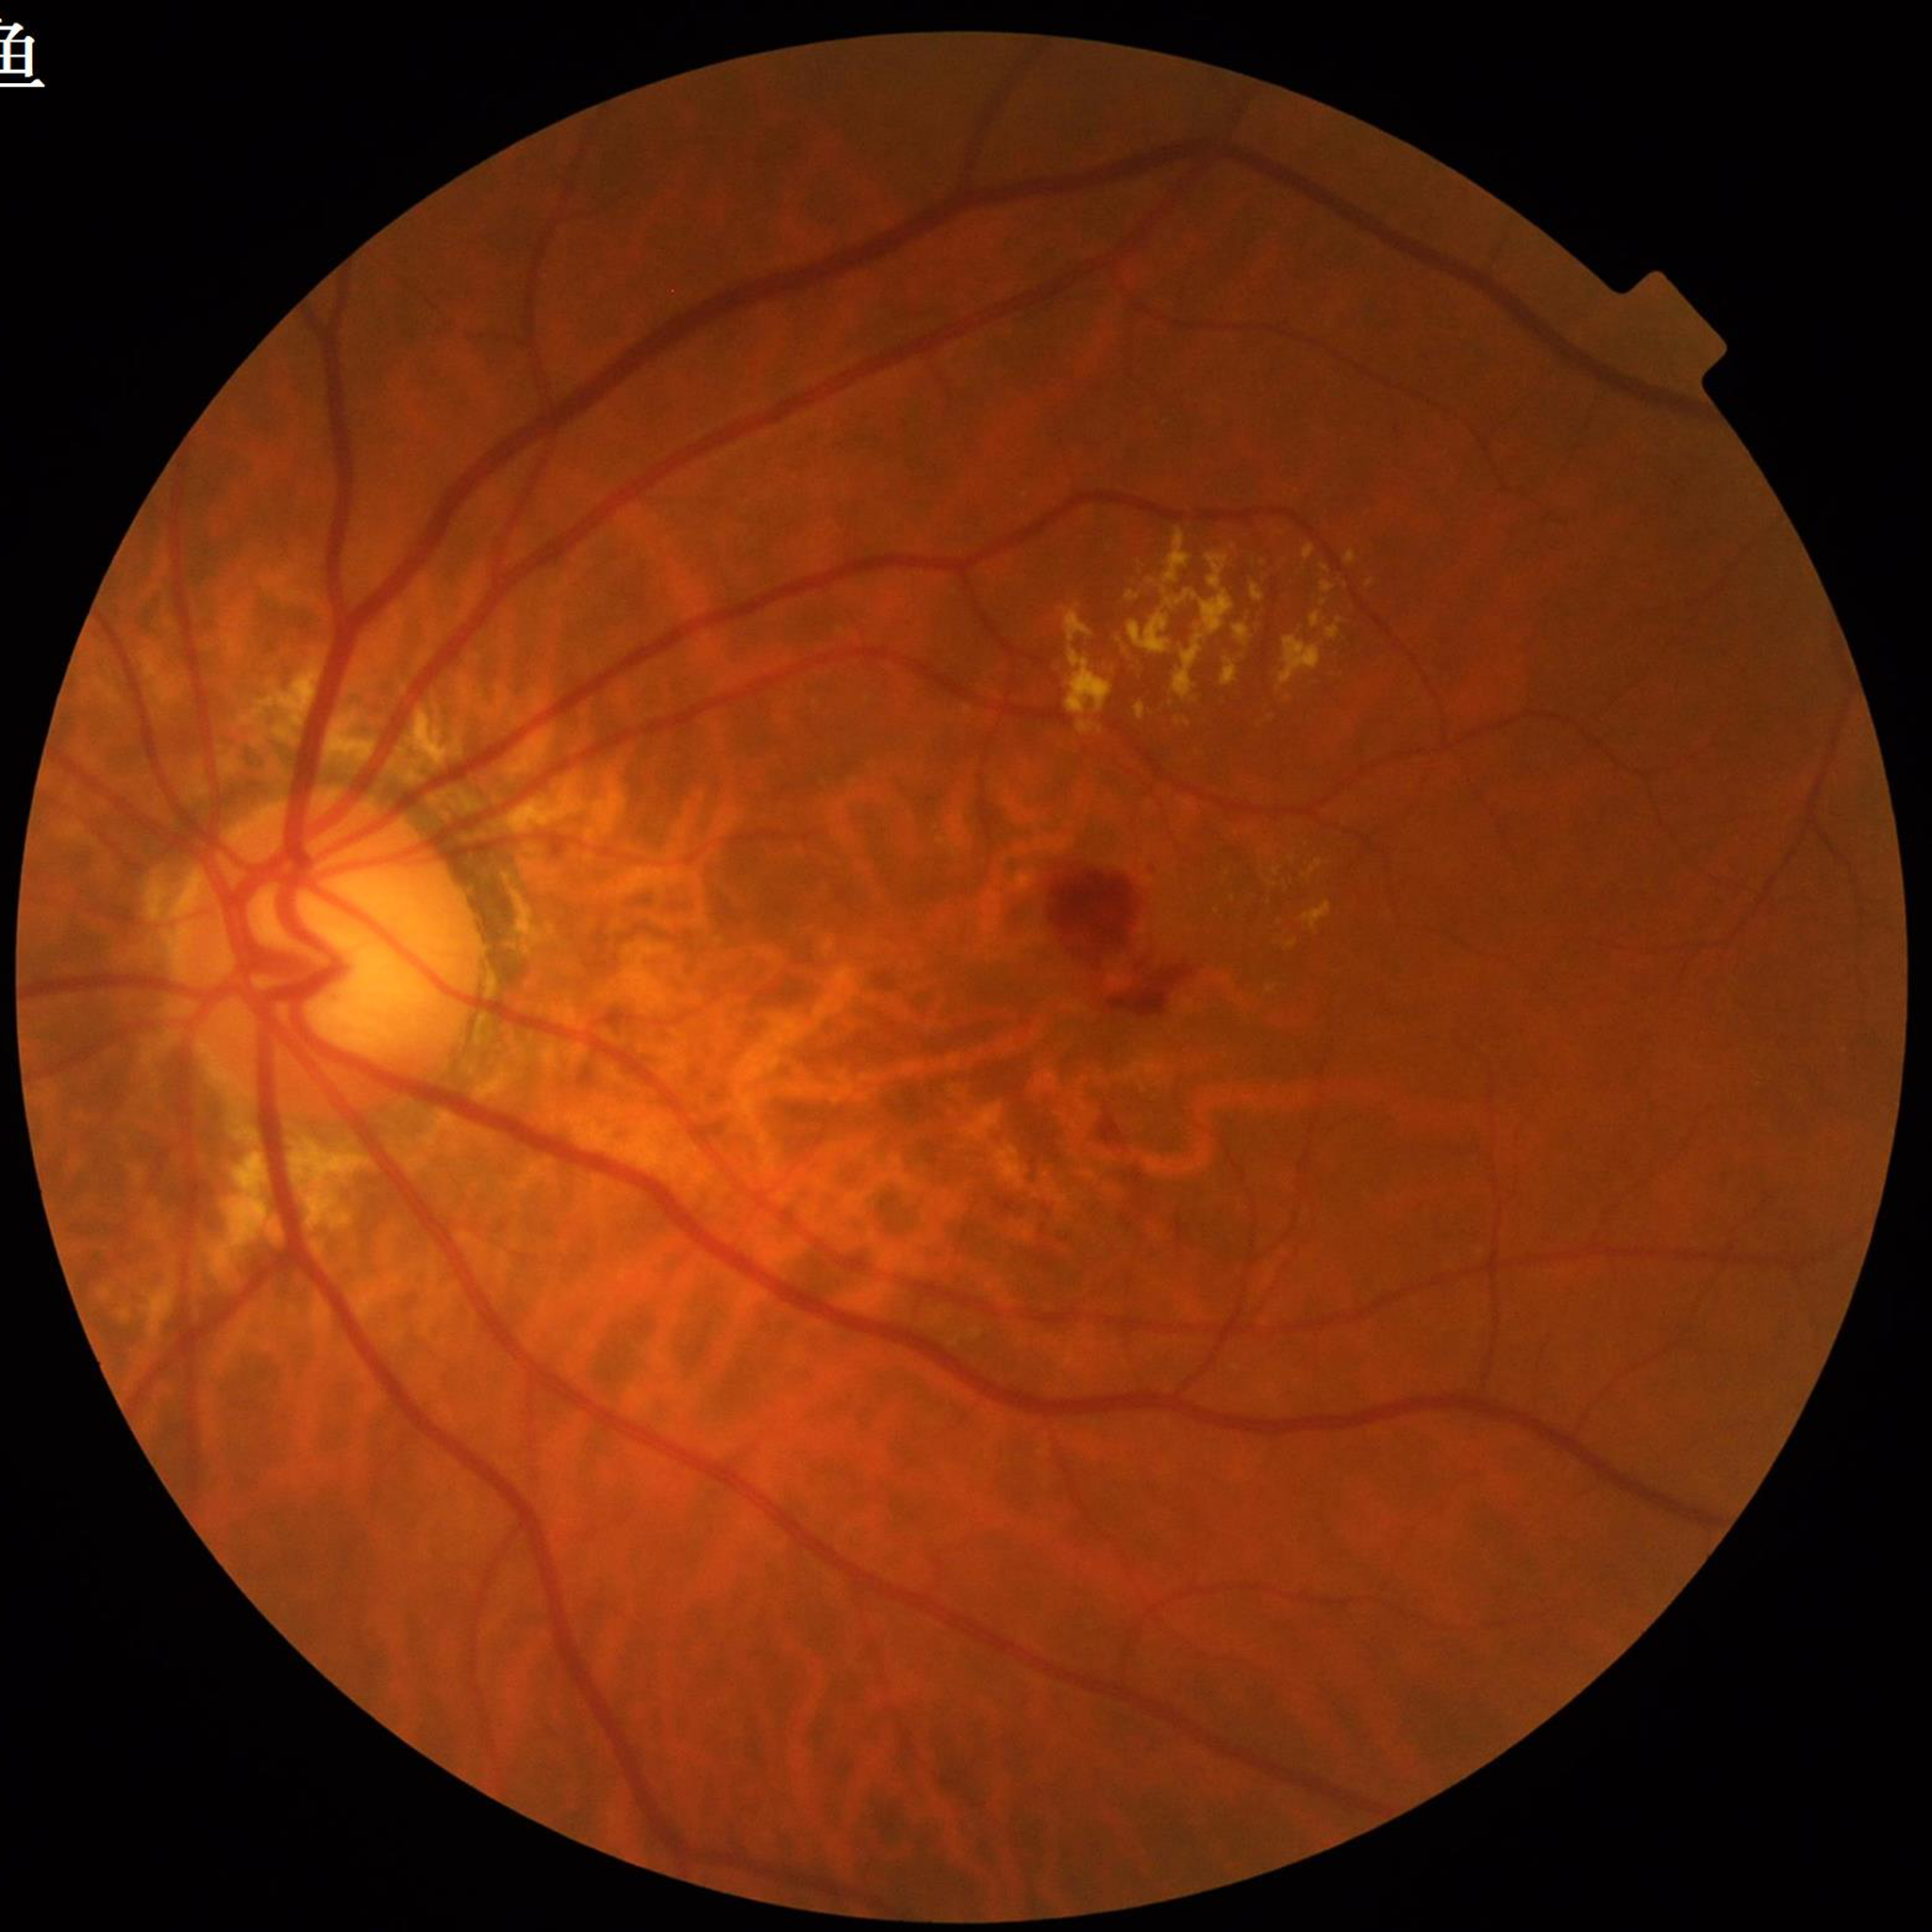

Patient diagnosed with AMD. Photo quality: good.